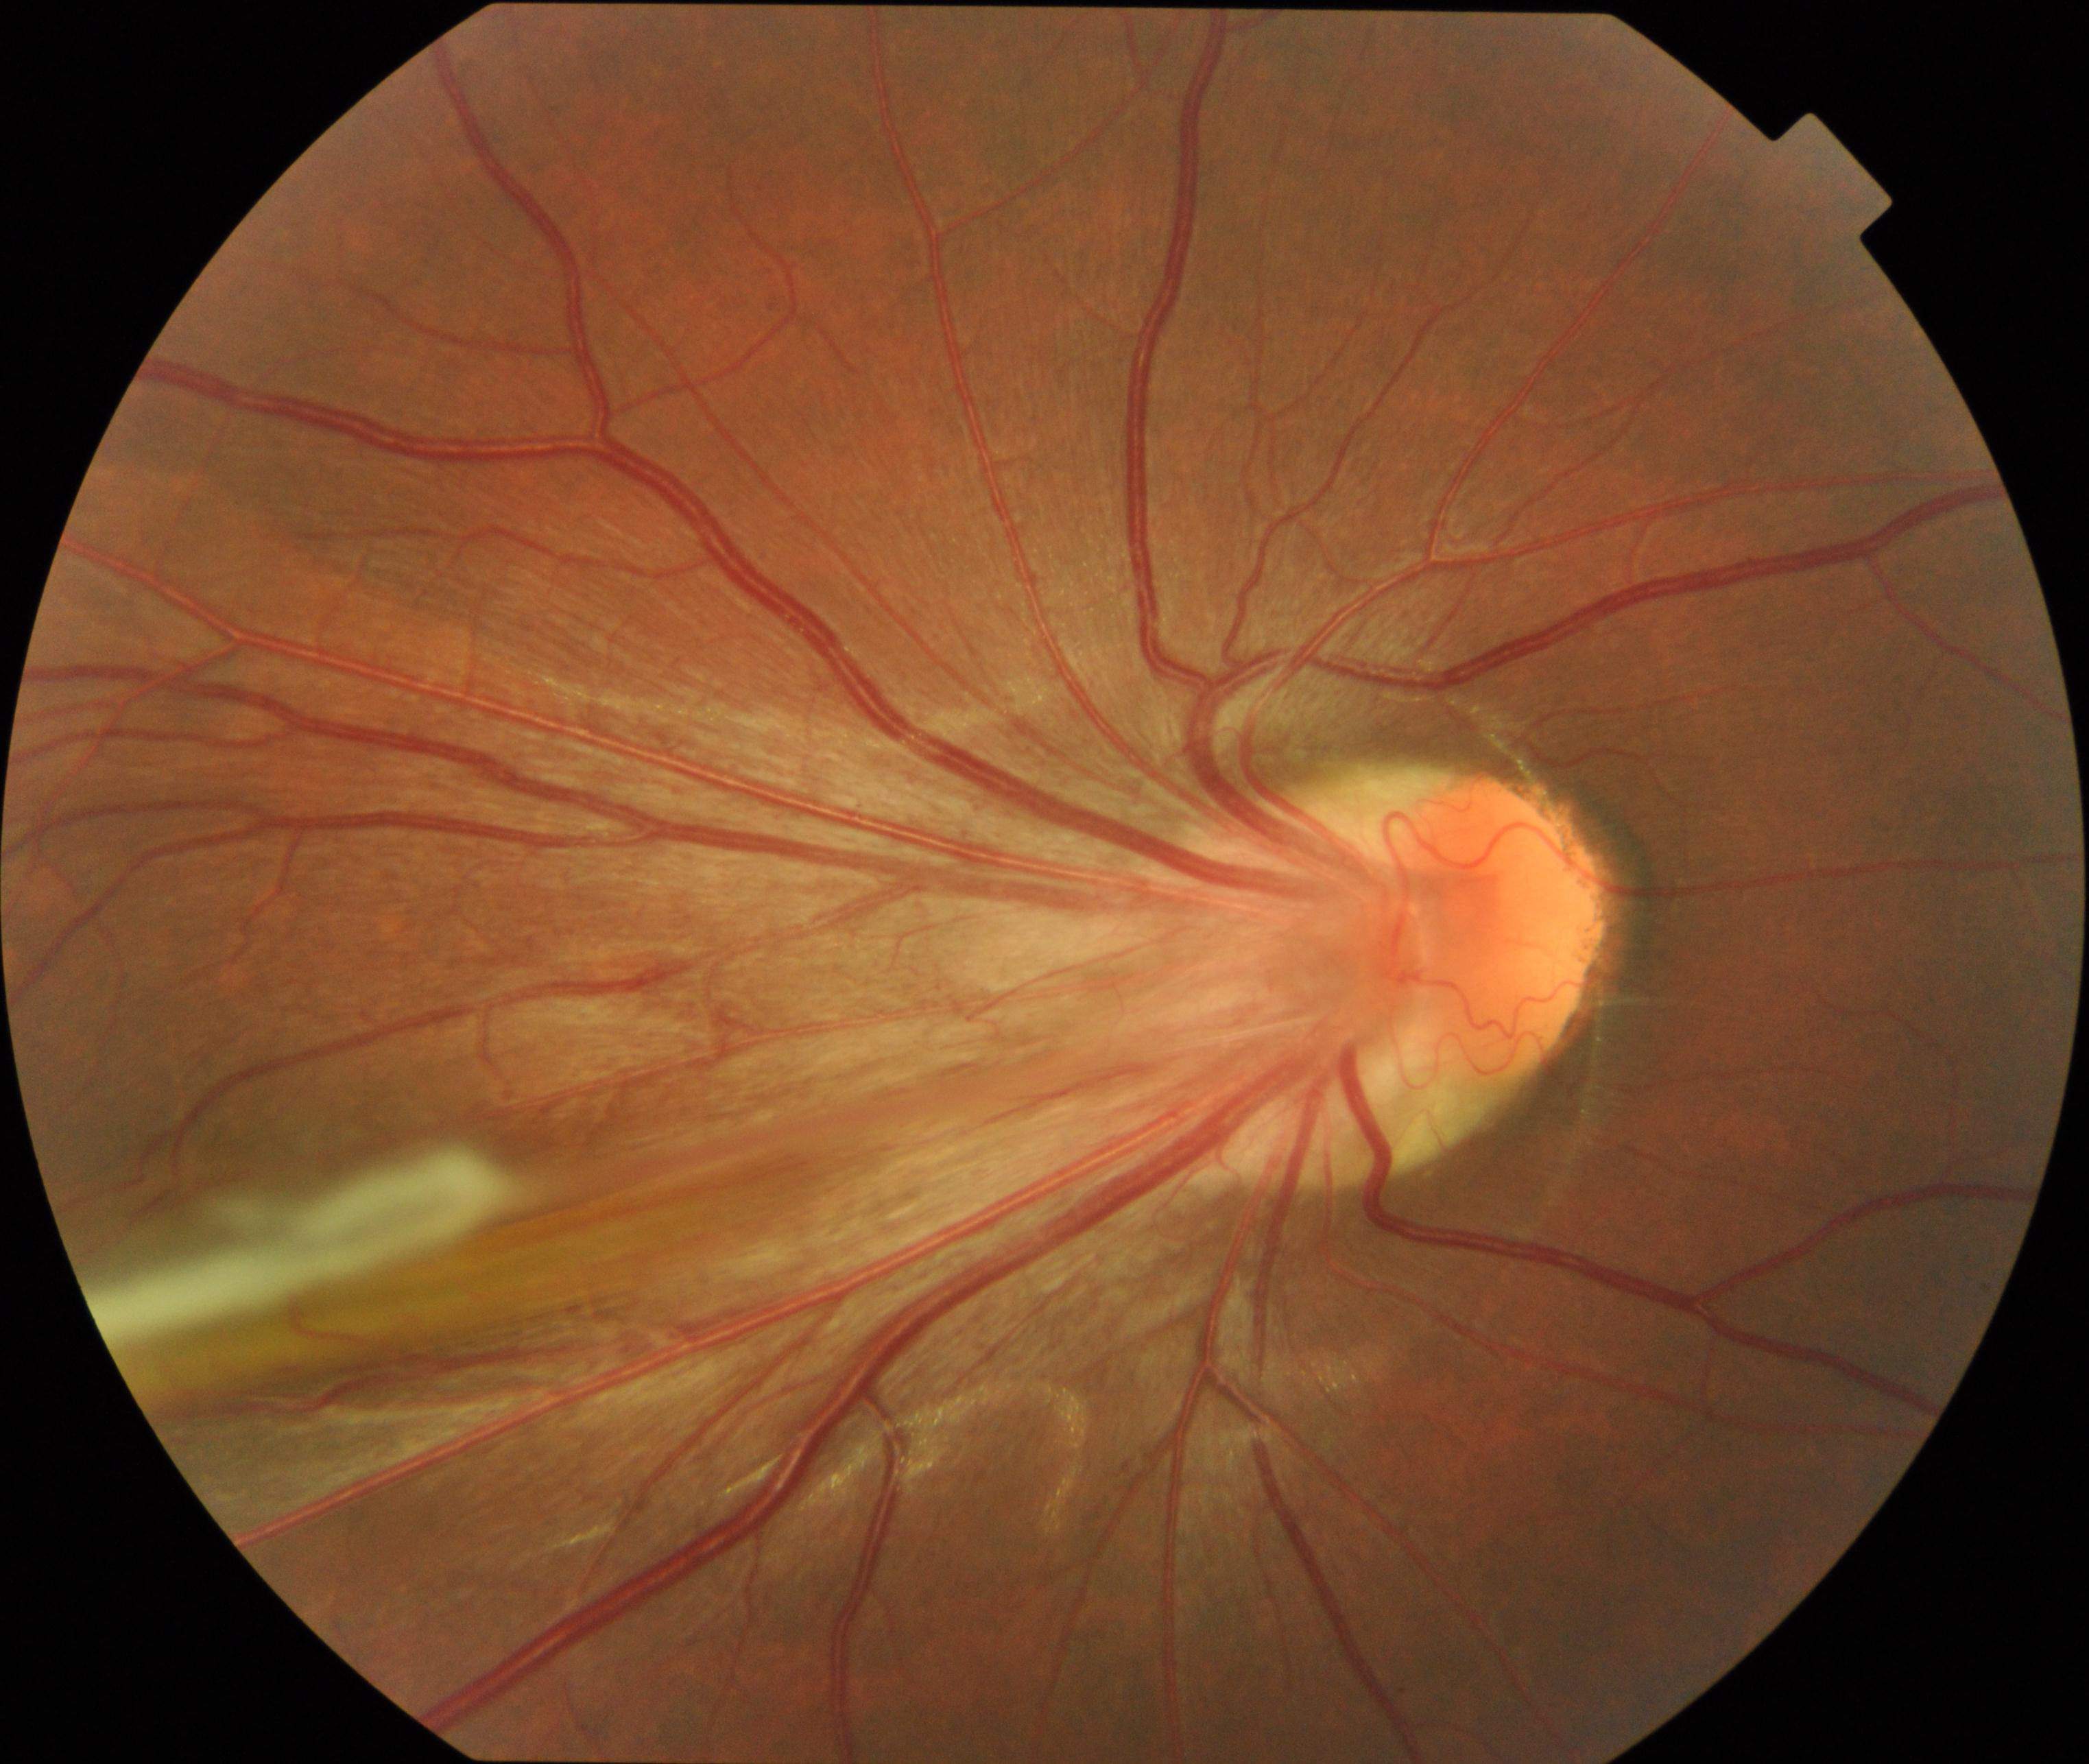 Primary finding: dragged disc. Typically showing temporal vascular straightening, retinal fold, or vitreous bands extending from the peripheral retina to the disc.